Nonmydriatic, 848x848 — 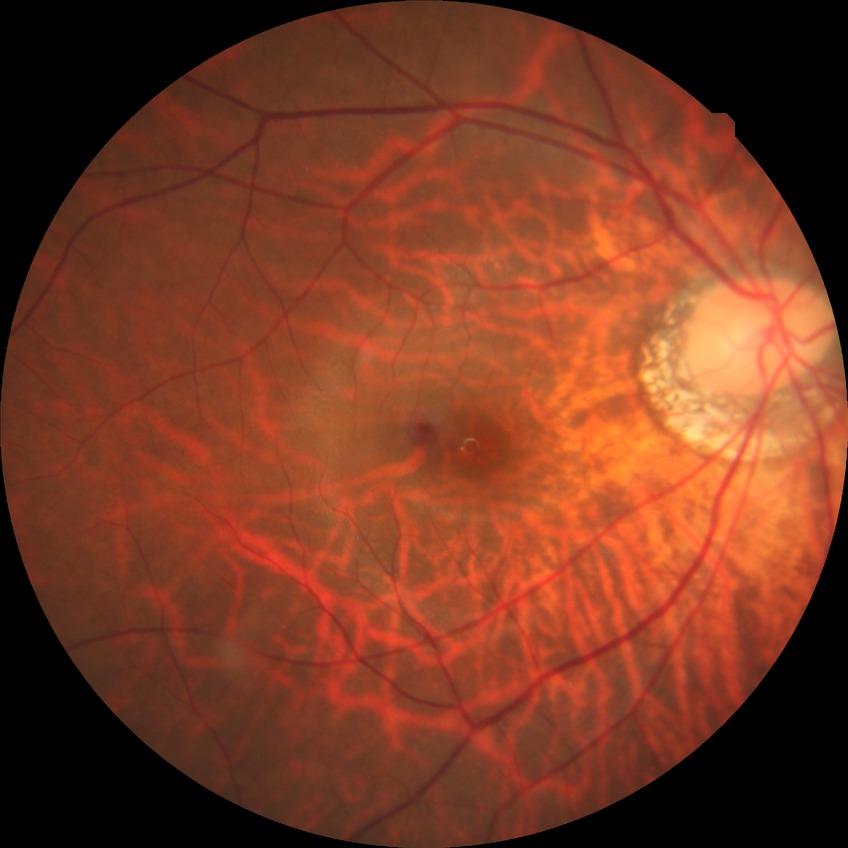
Diabetic retinopathy (DR) is no diabetic retinopathy (NDR).